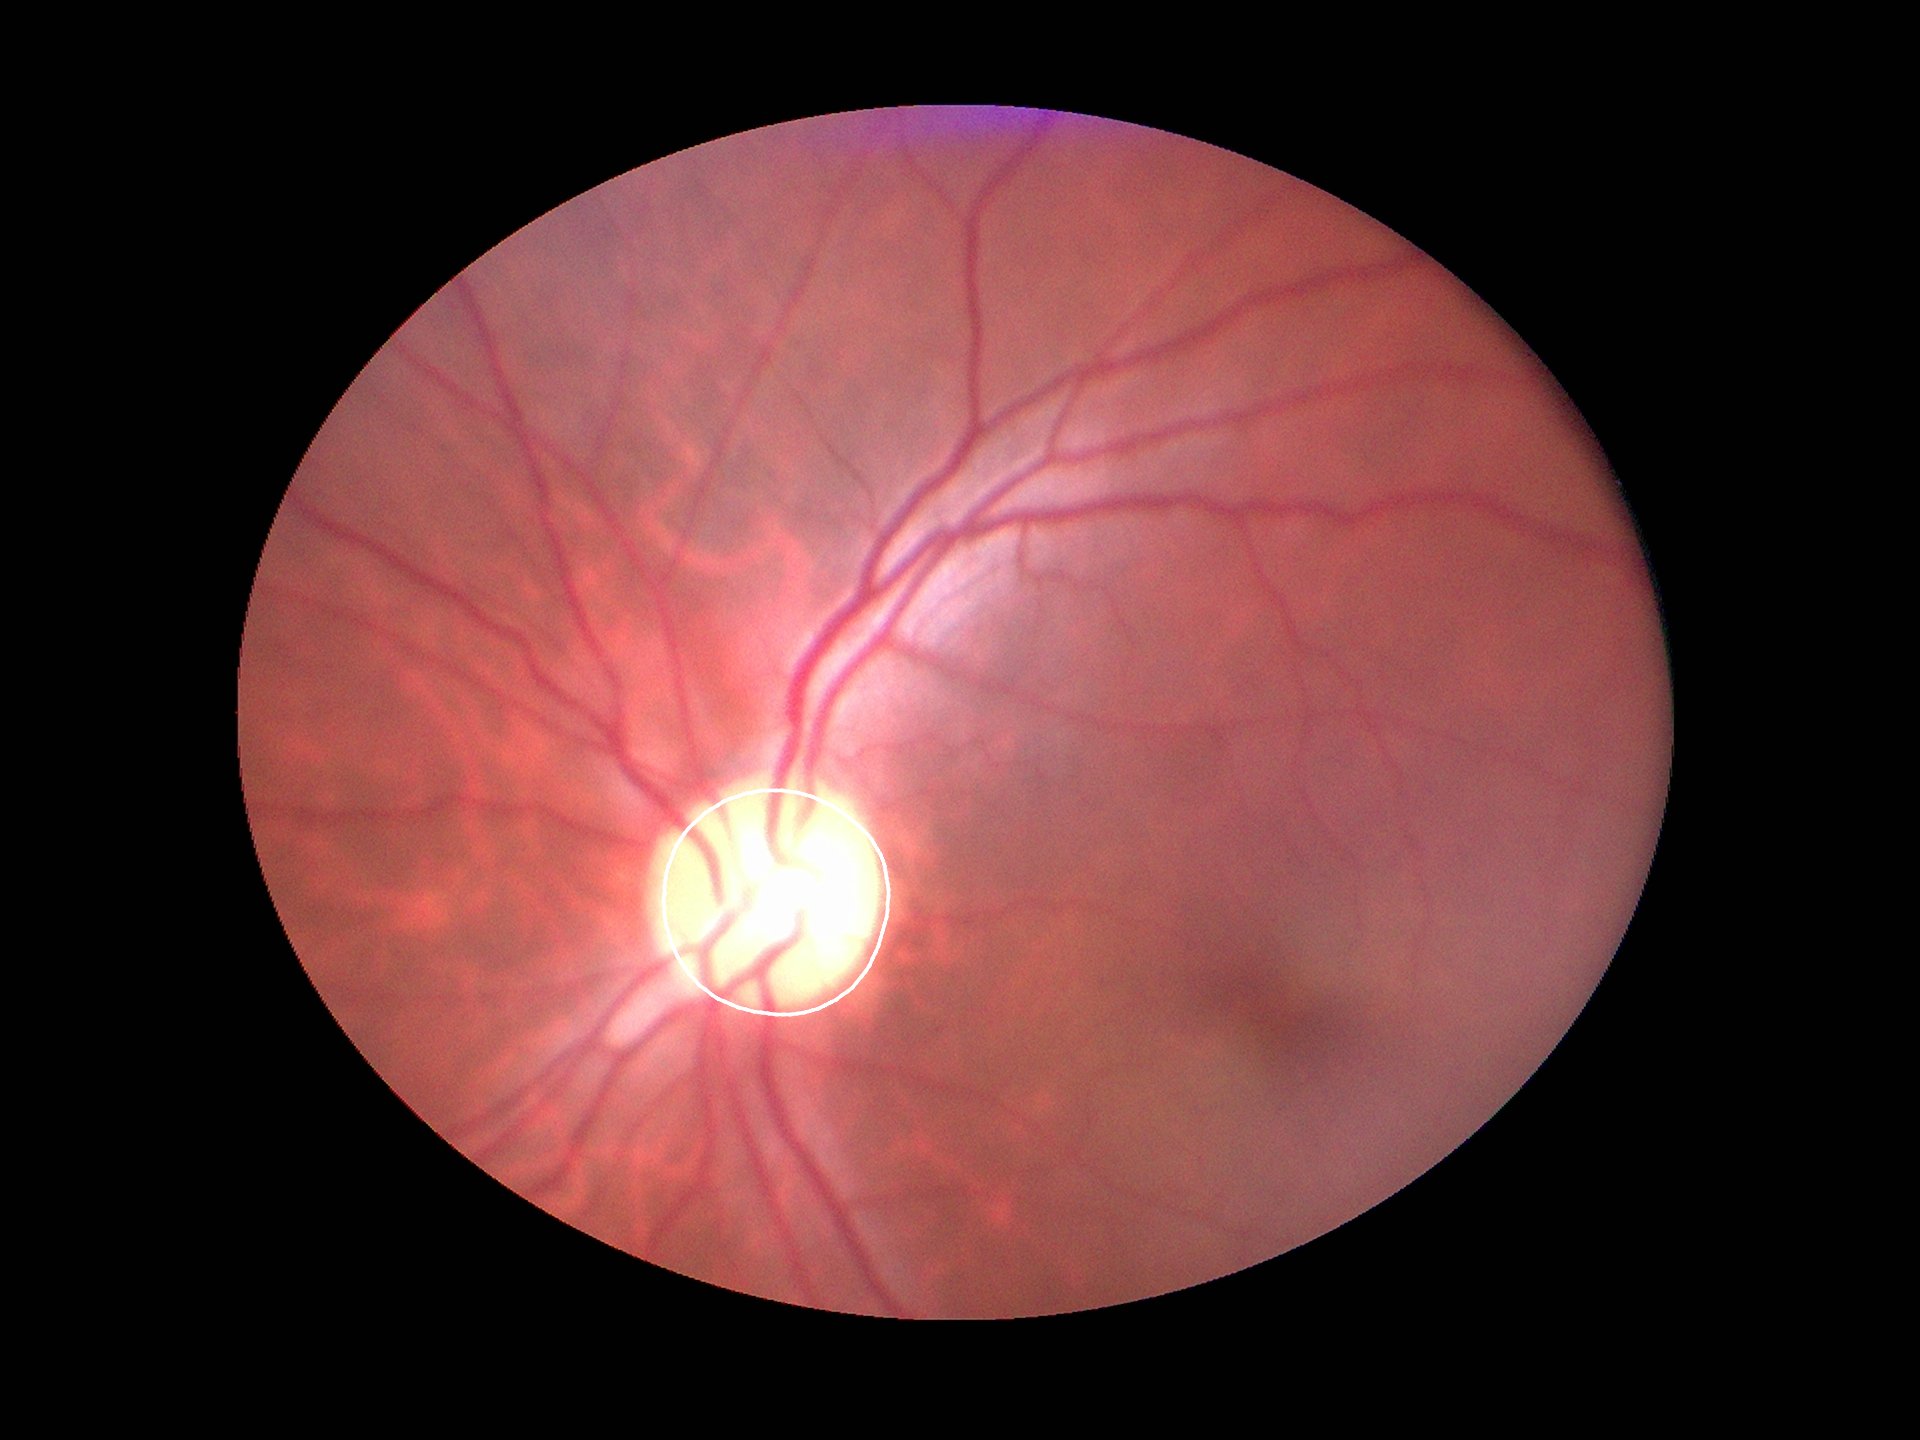
{"hcdr": "0.55", "vcdr": "0.54", "glaucoma_decision": "no suspicious findings (1 of 5 graders flagged glaucoma suspect)"}